NIDEK AFC-230. 848 x 848 pixels. Diabetic retinopathy graded by the modified Davis classification. Without pupil dilation
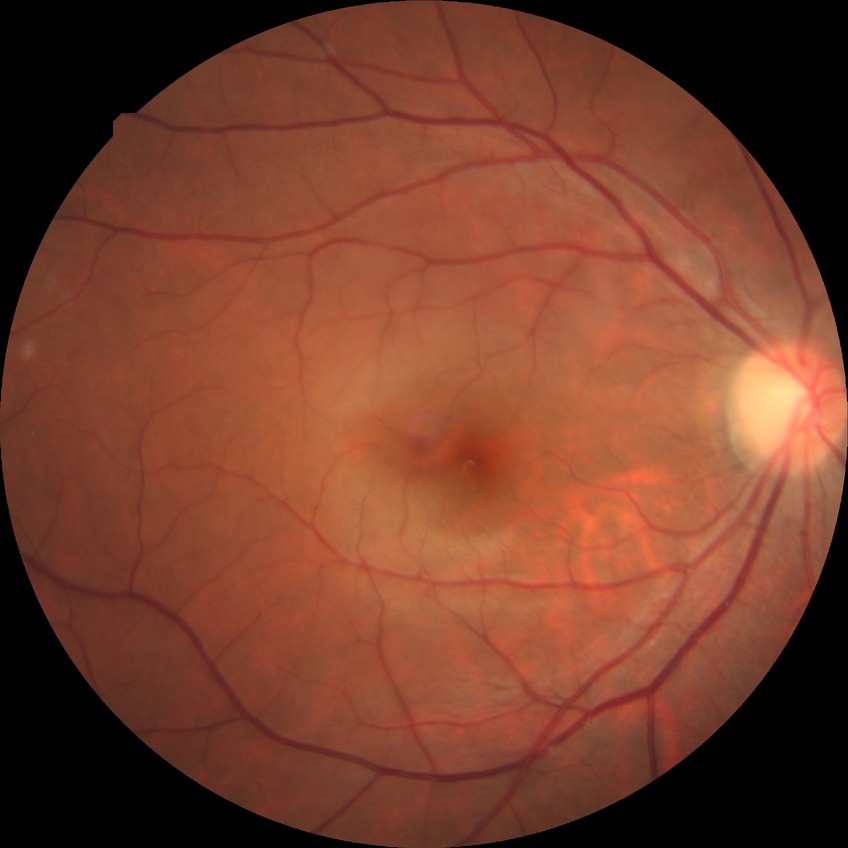 Diabetic retinopathy (DR): no diabetic retinopathy (NDR).